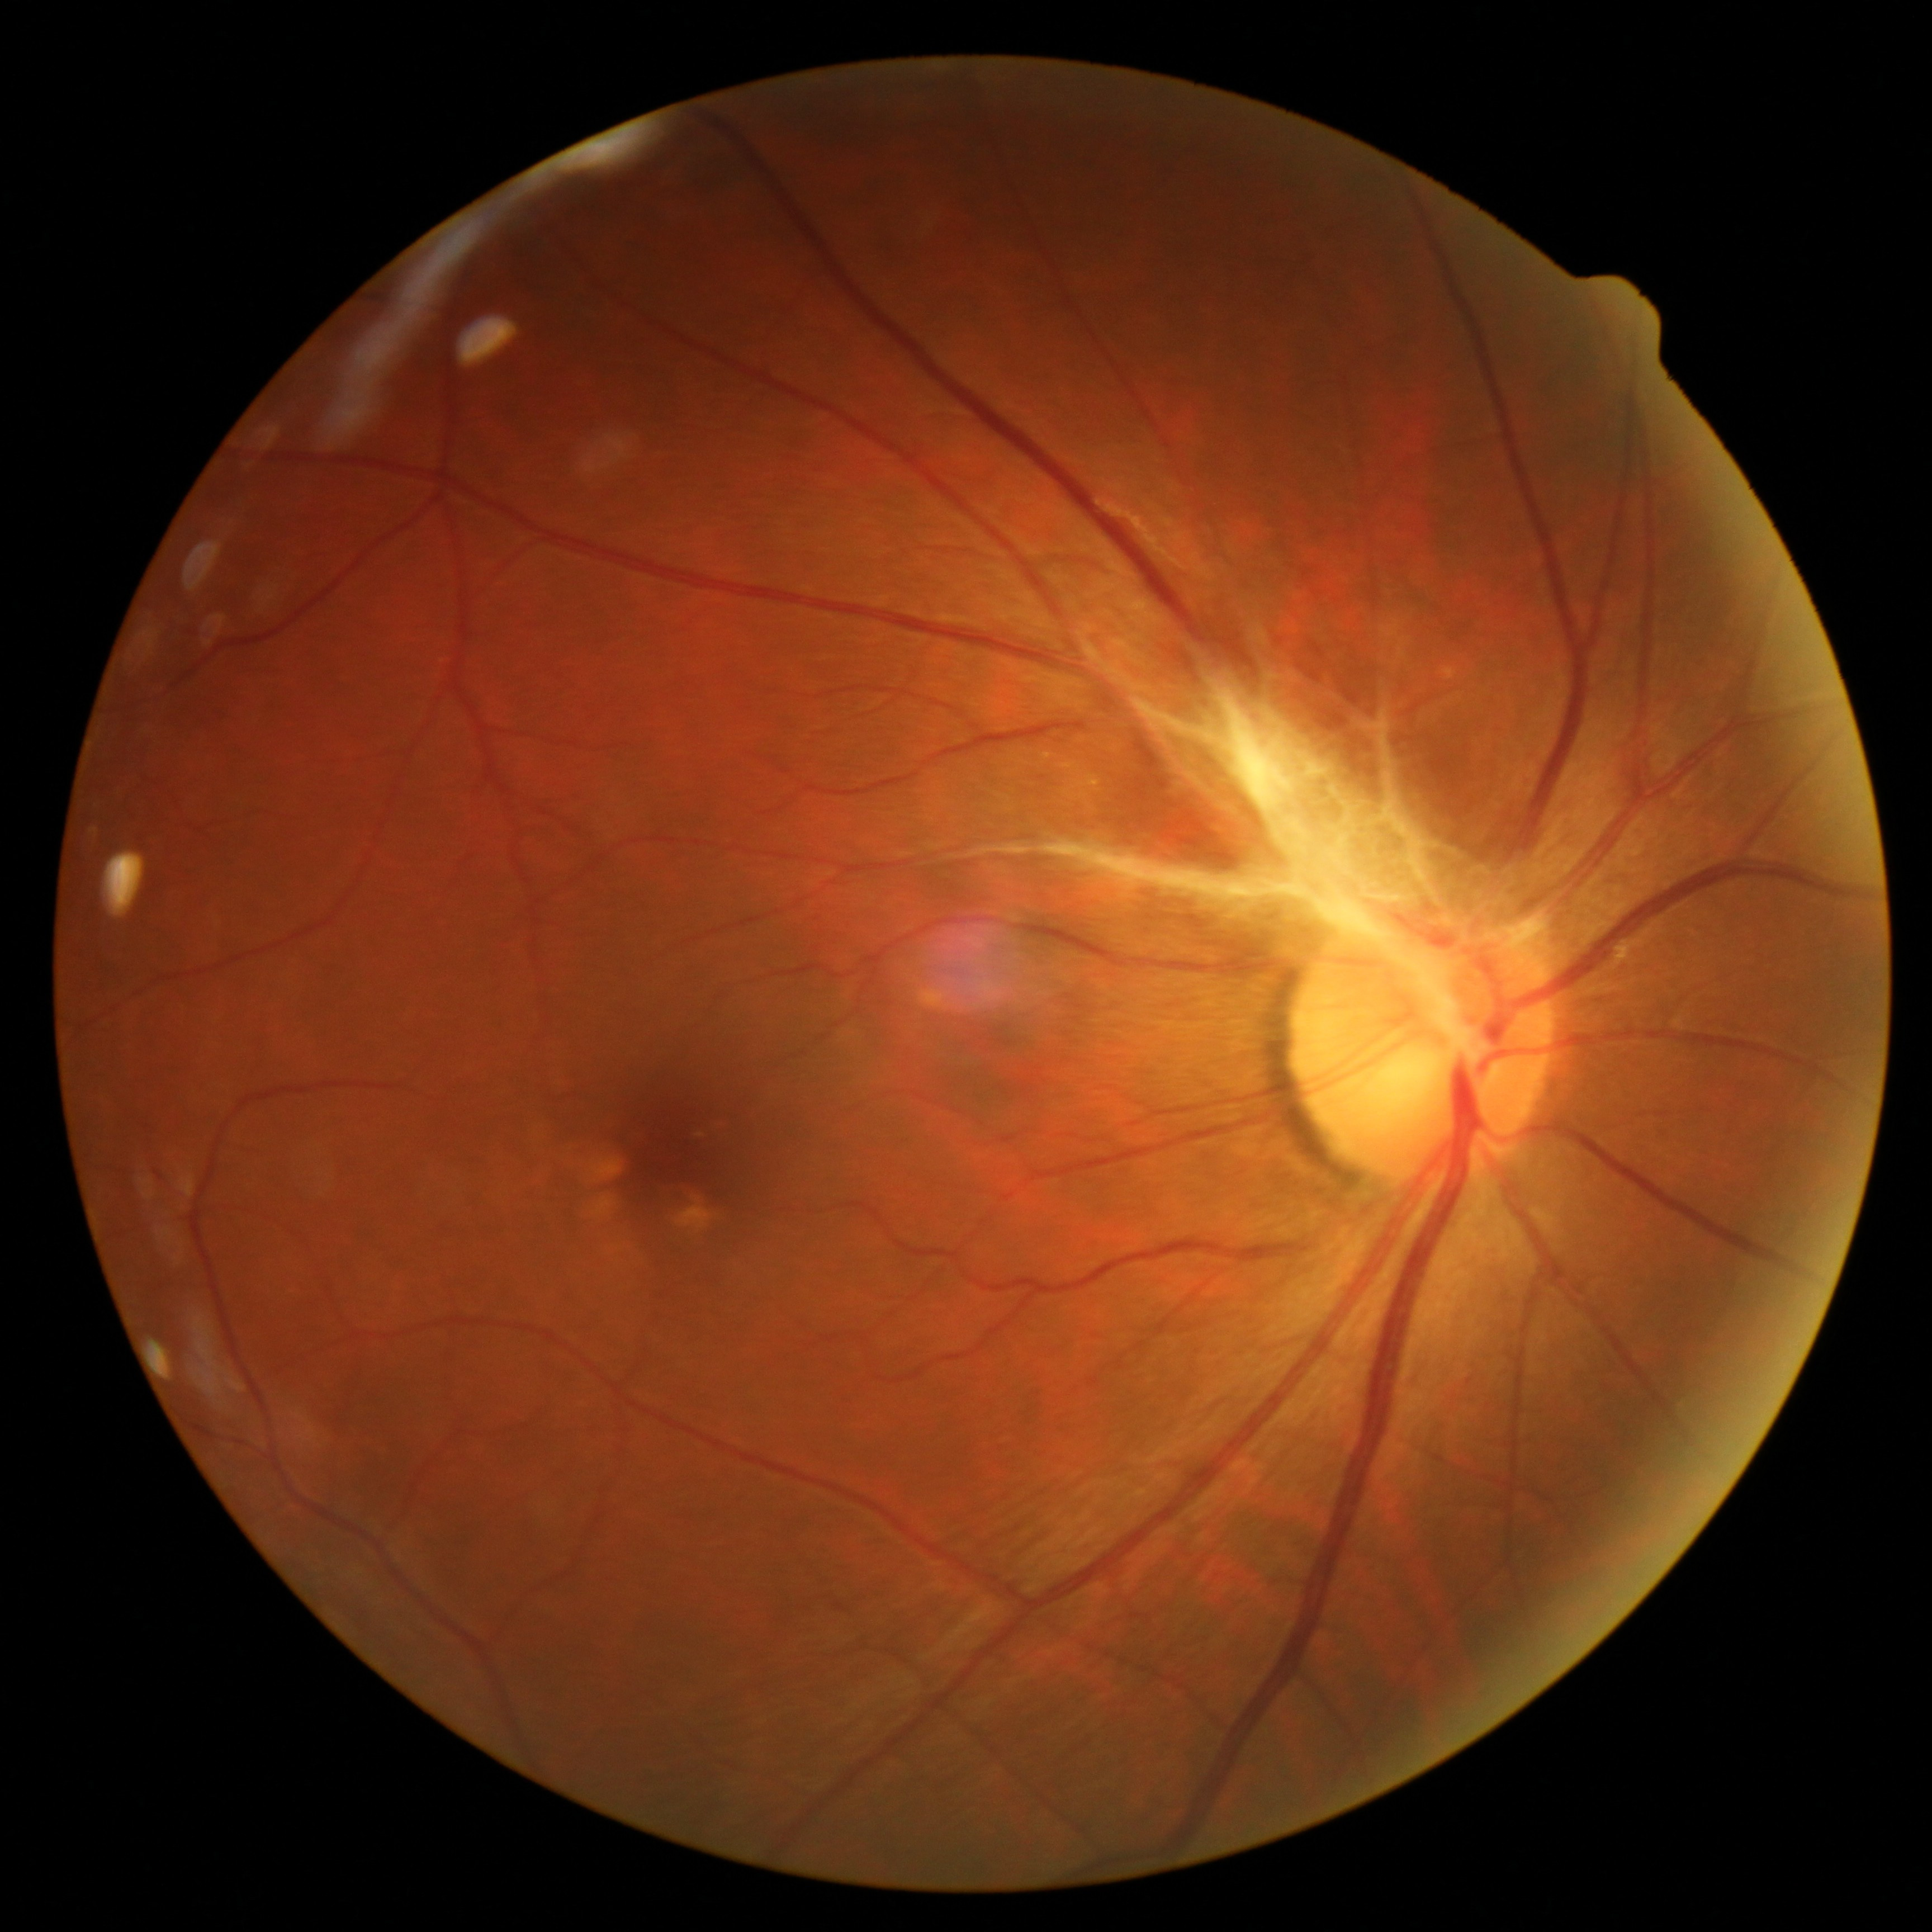 diabetic retinopathy (DR) = 4/4.